DR severity per modified Davis staging — 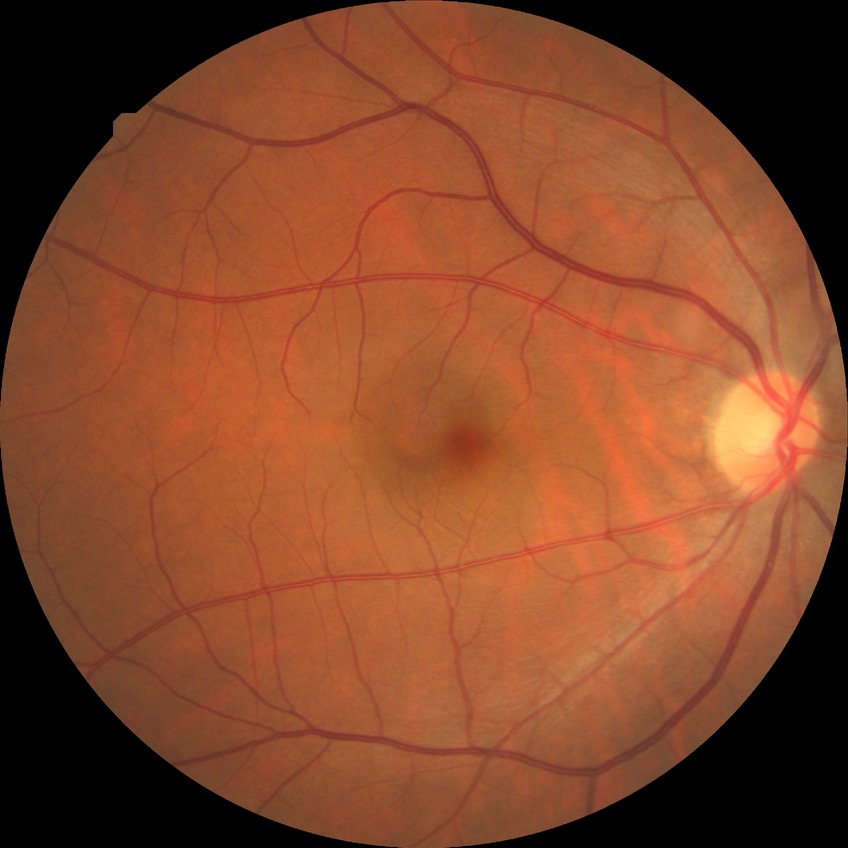
diabetic retinopathy (DR) = no diabetic retinopathy (NDR).